1380x1382; retinal fundus photograph
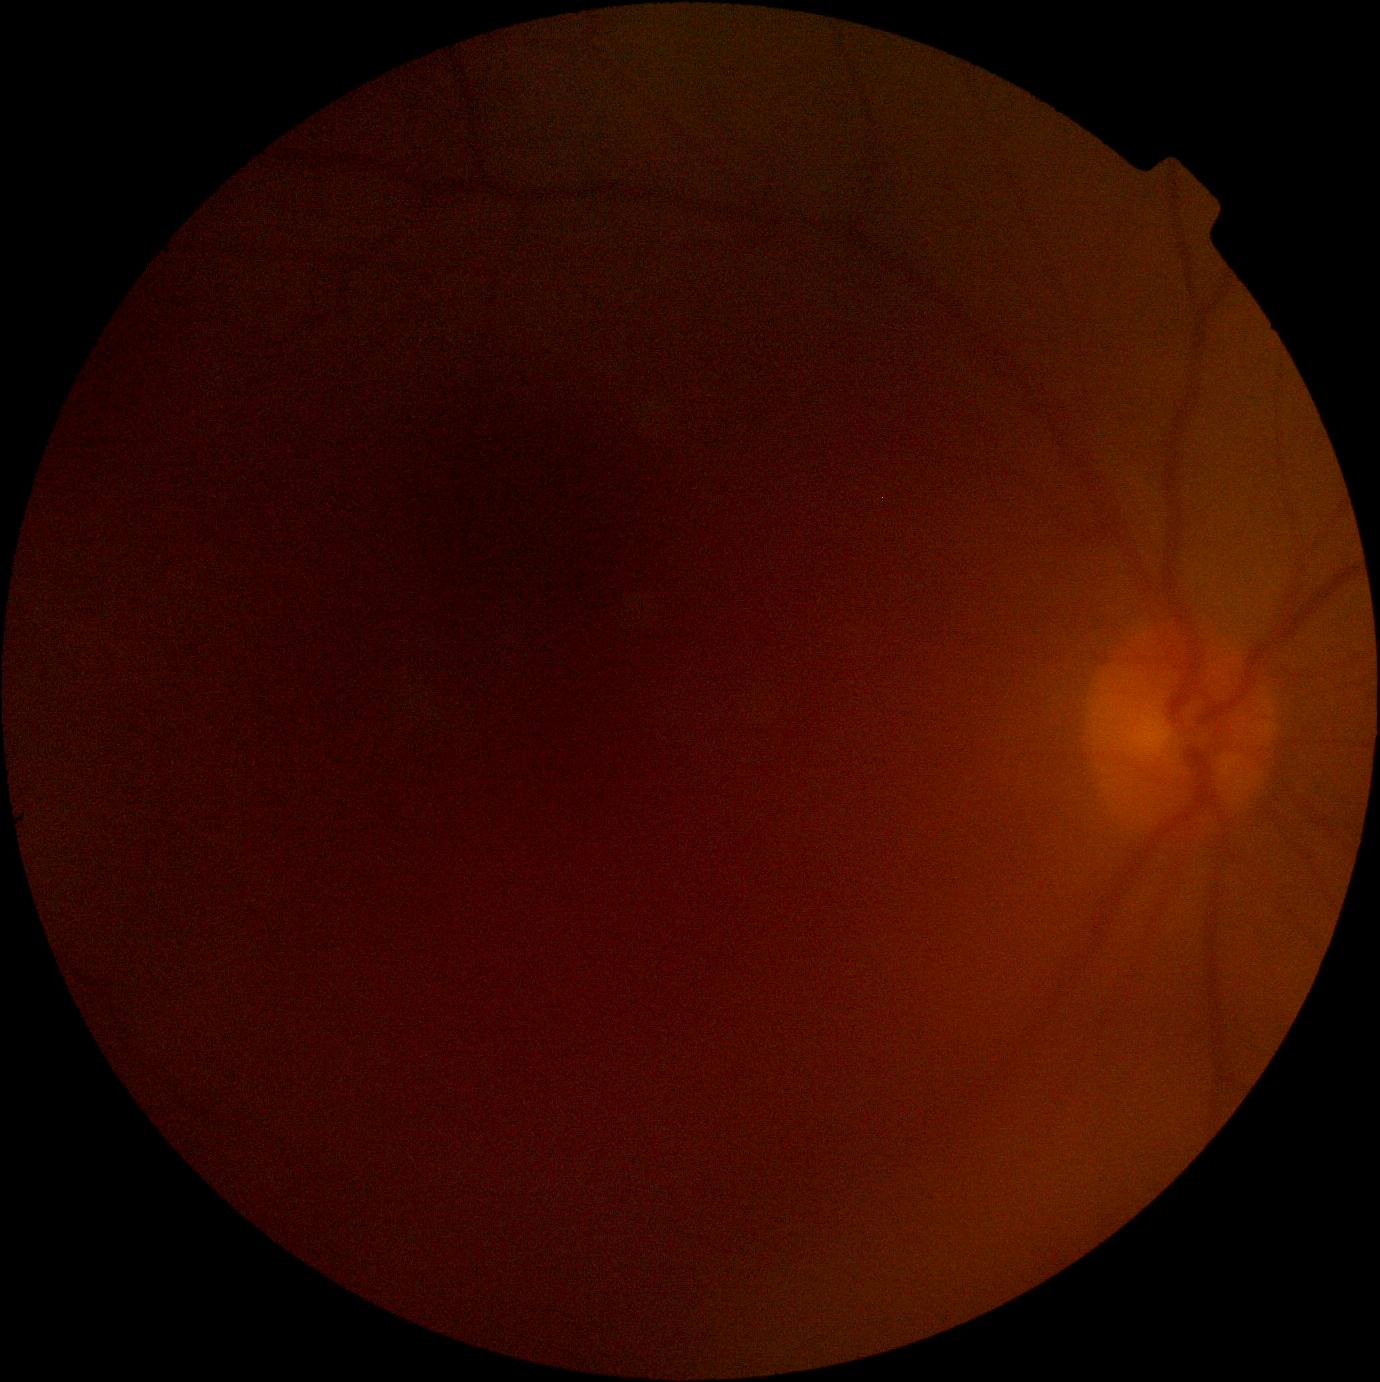

dr_grade: ungradable due to poor image quality